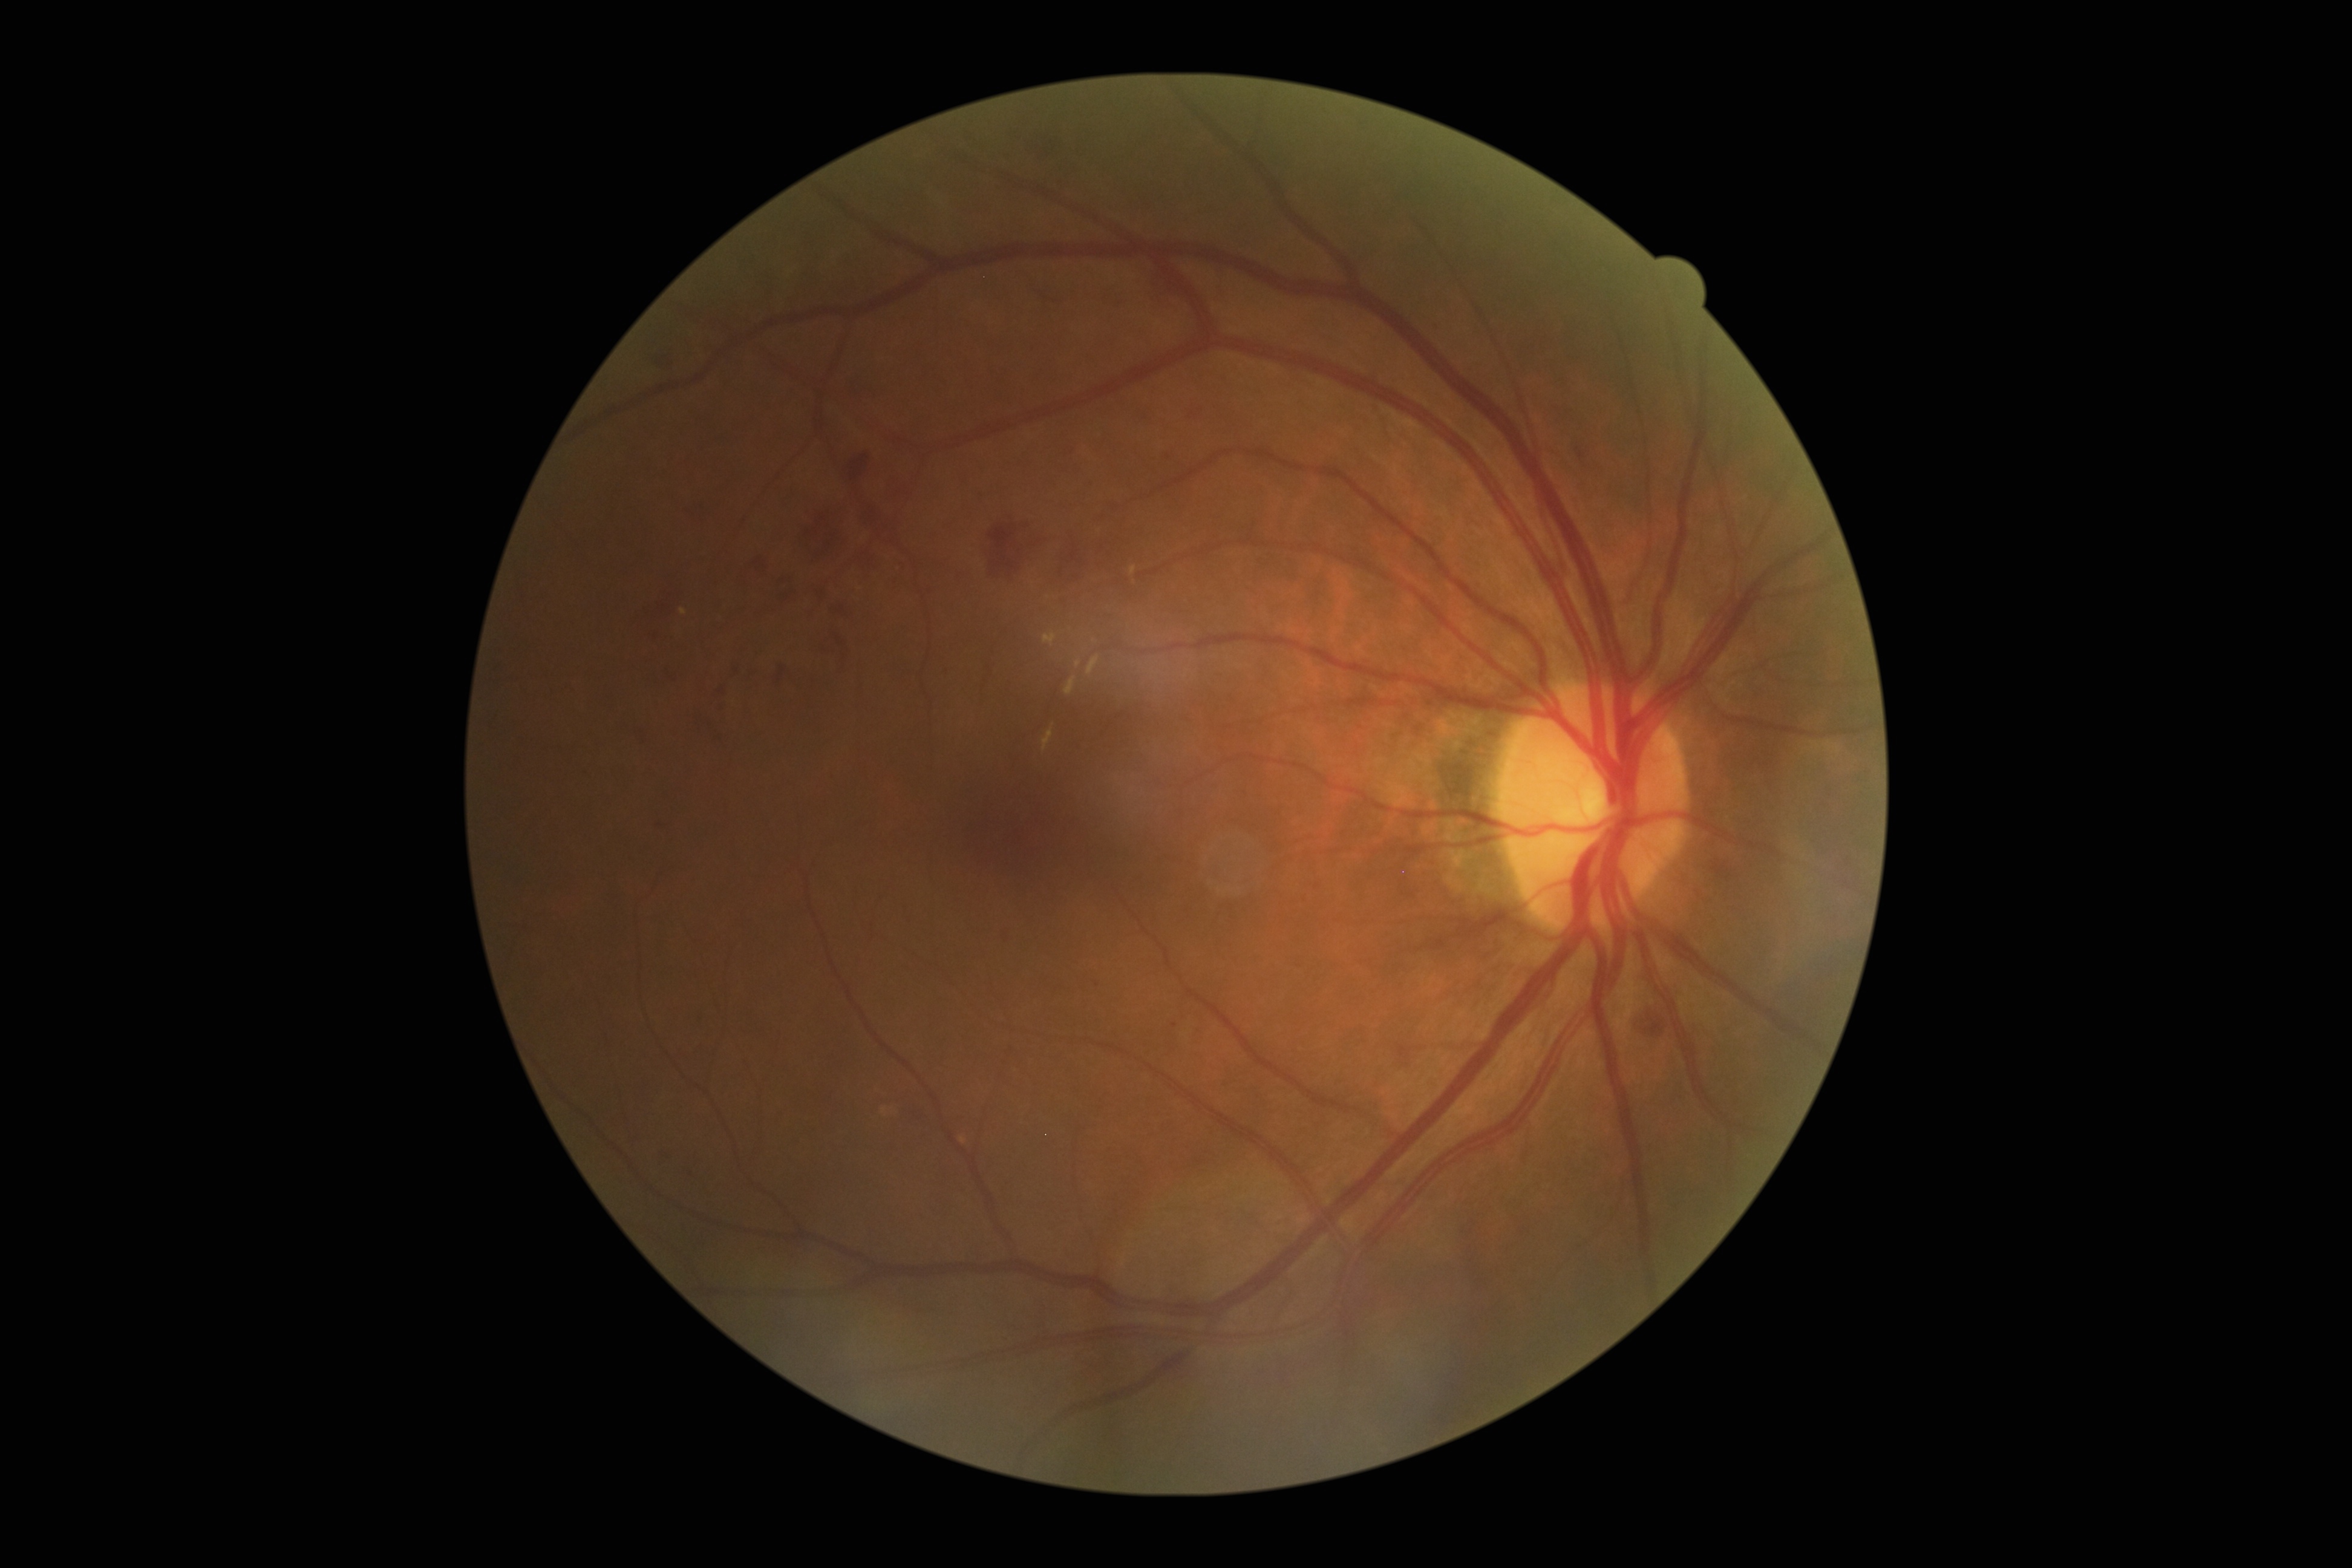 DR stage: grade 2 (moderate NPDR).